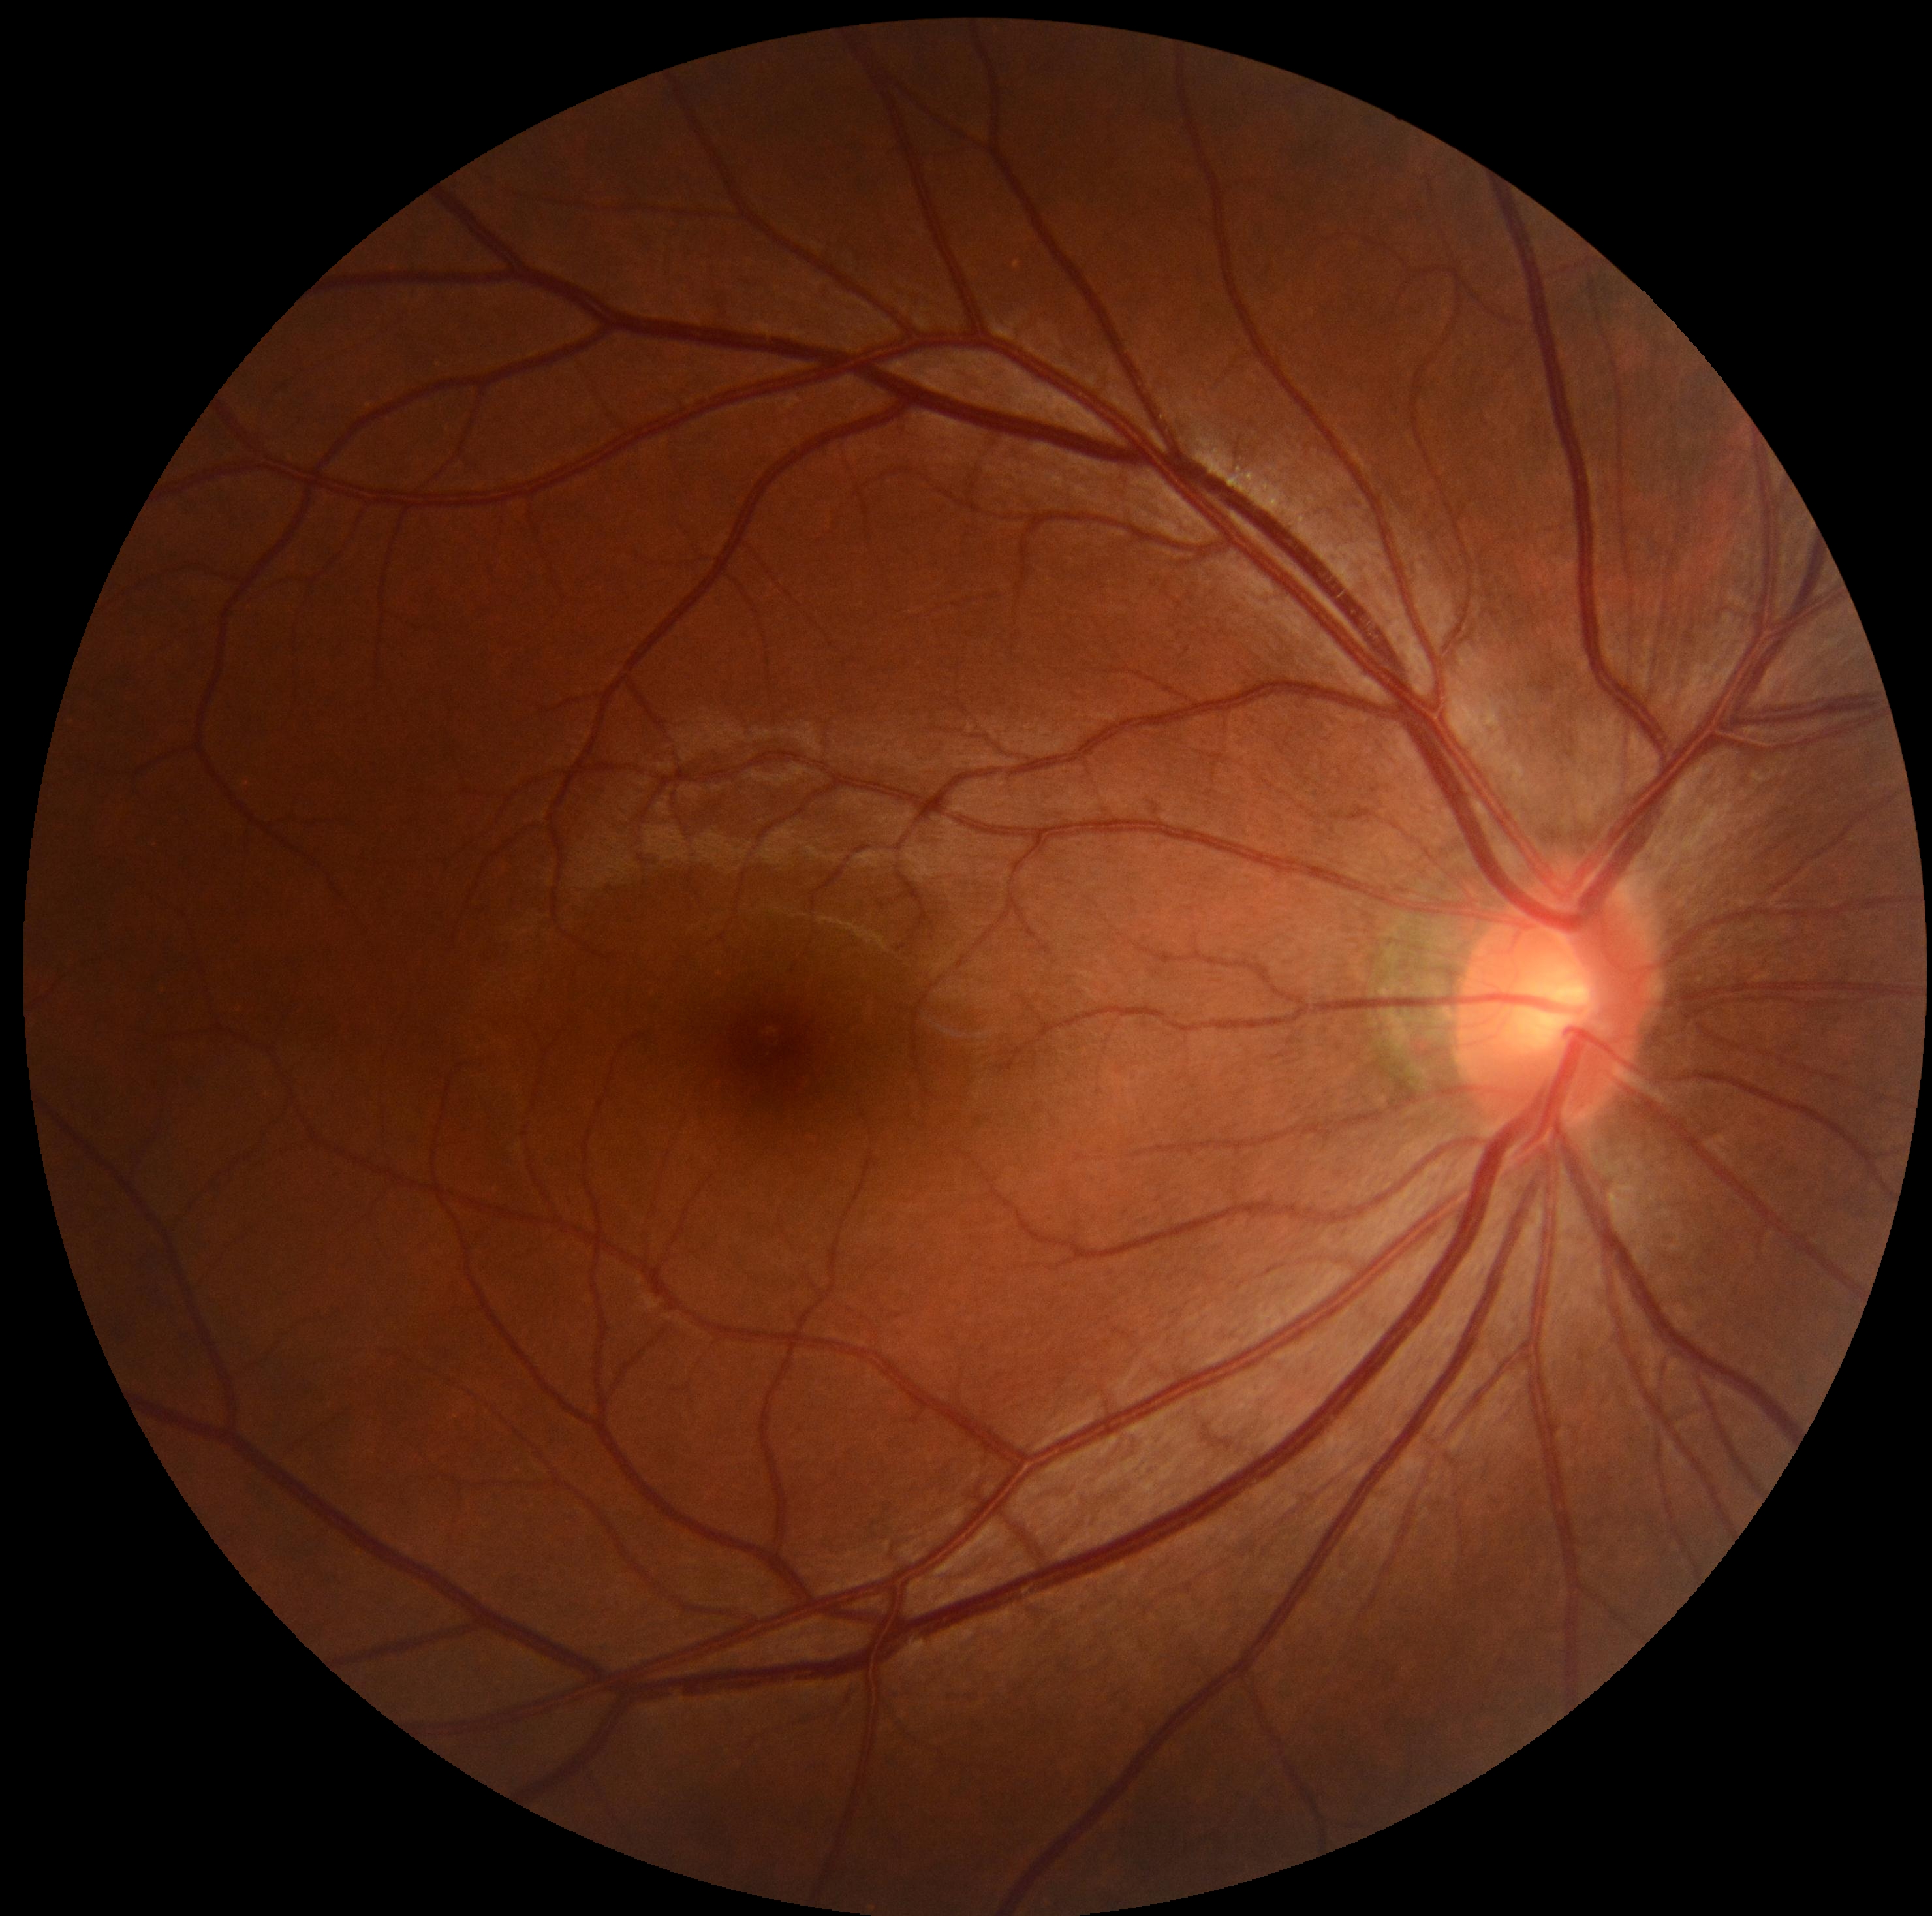 Diabetic retinopathy (DR): grade 0 (no apparent retinopathy).